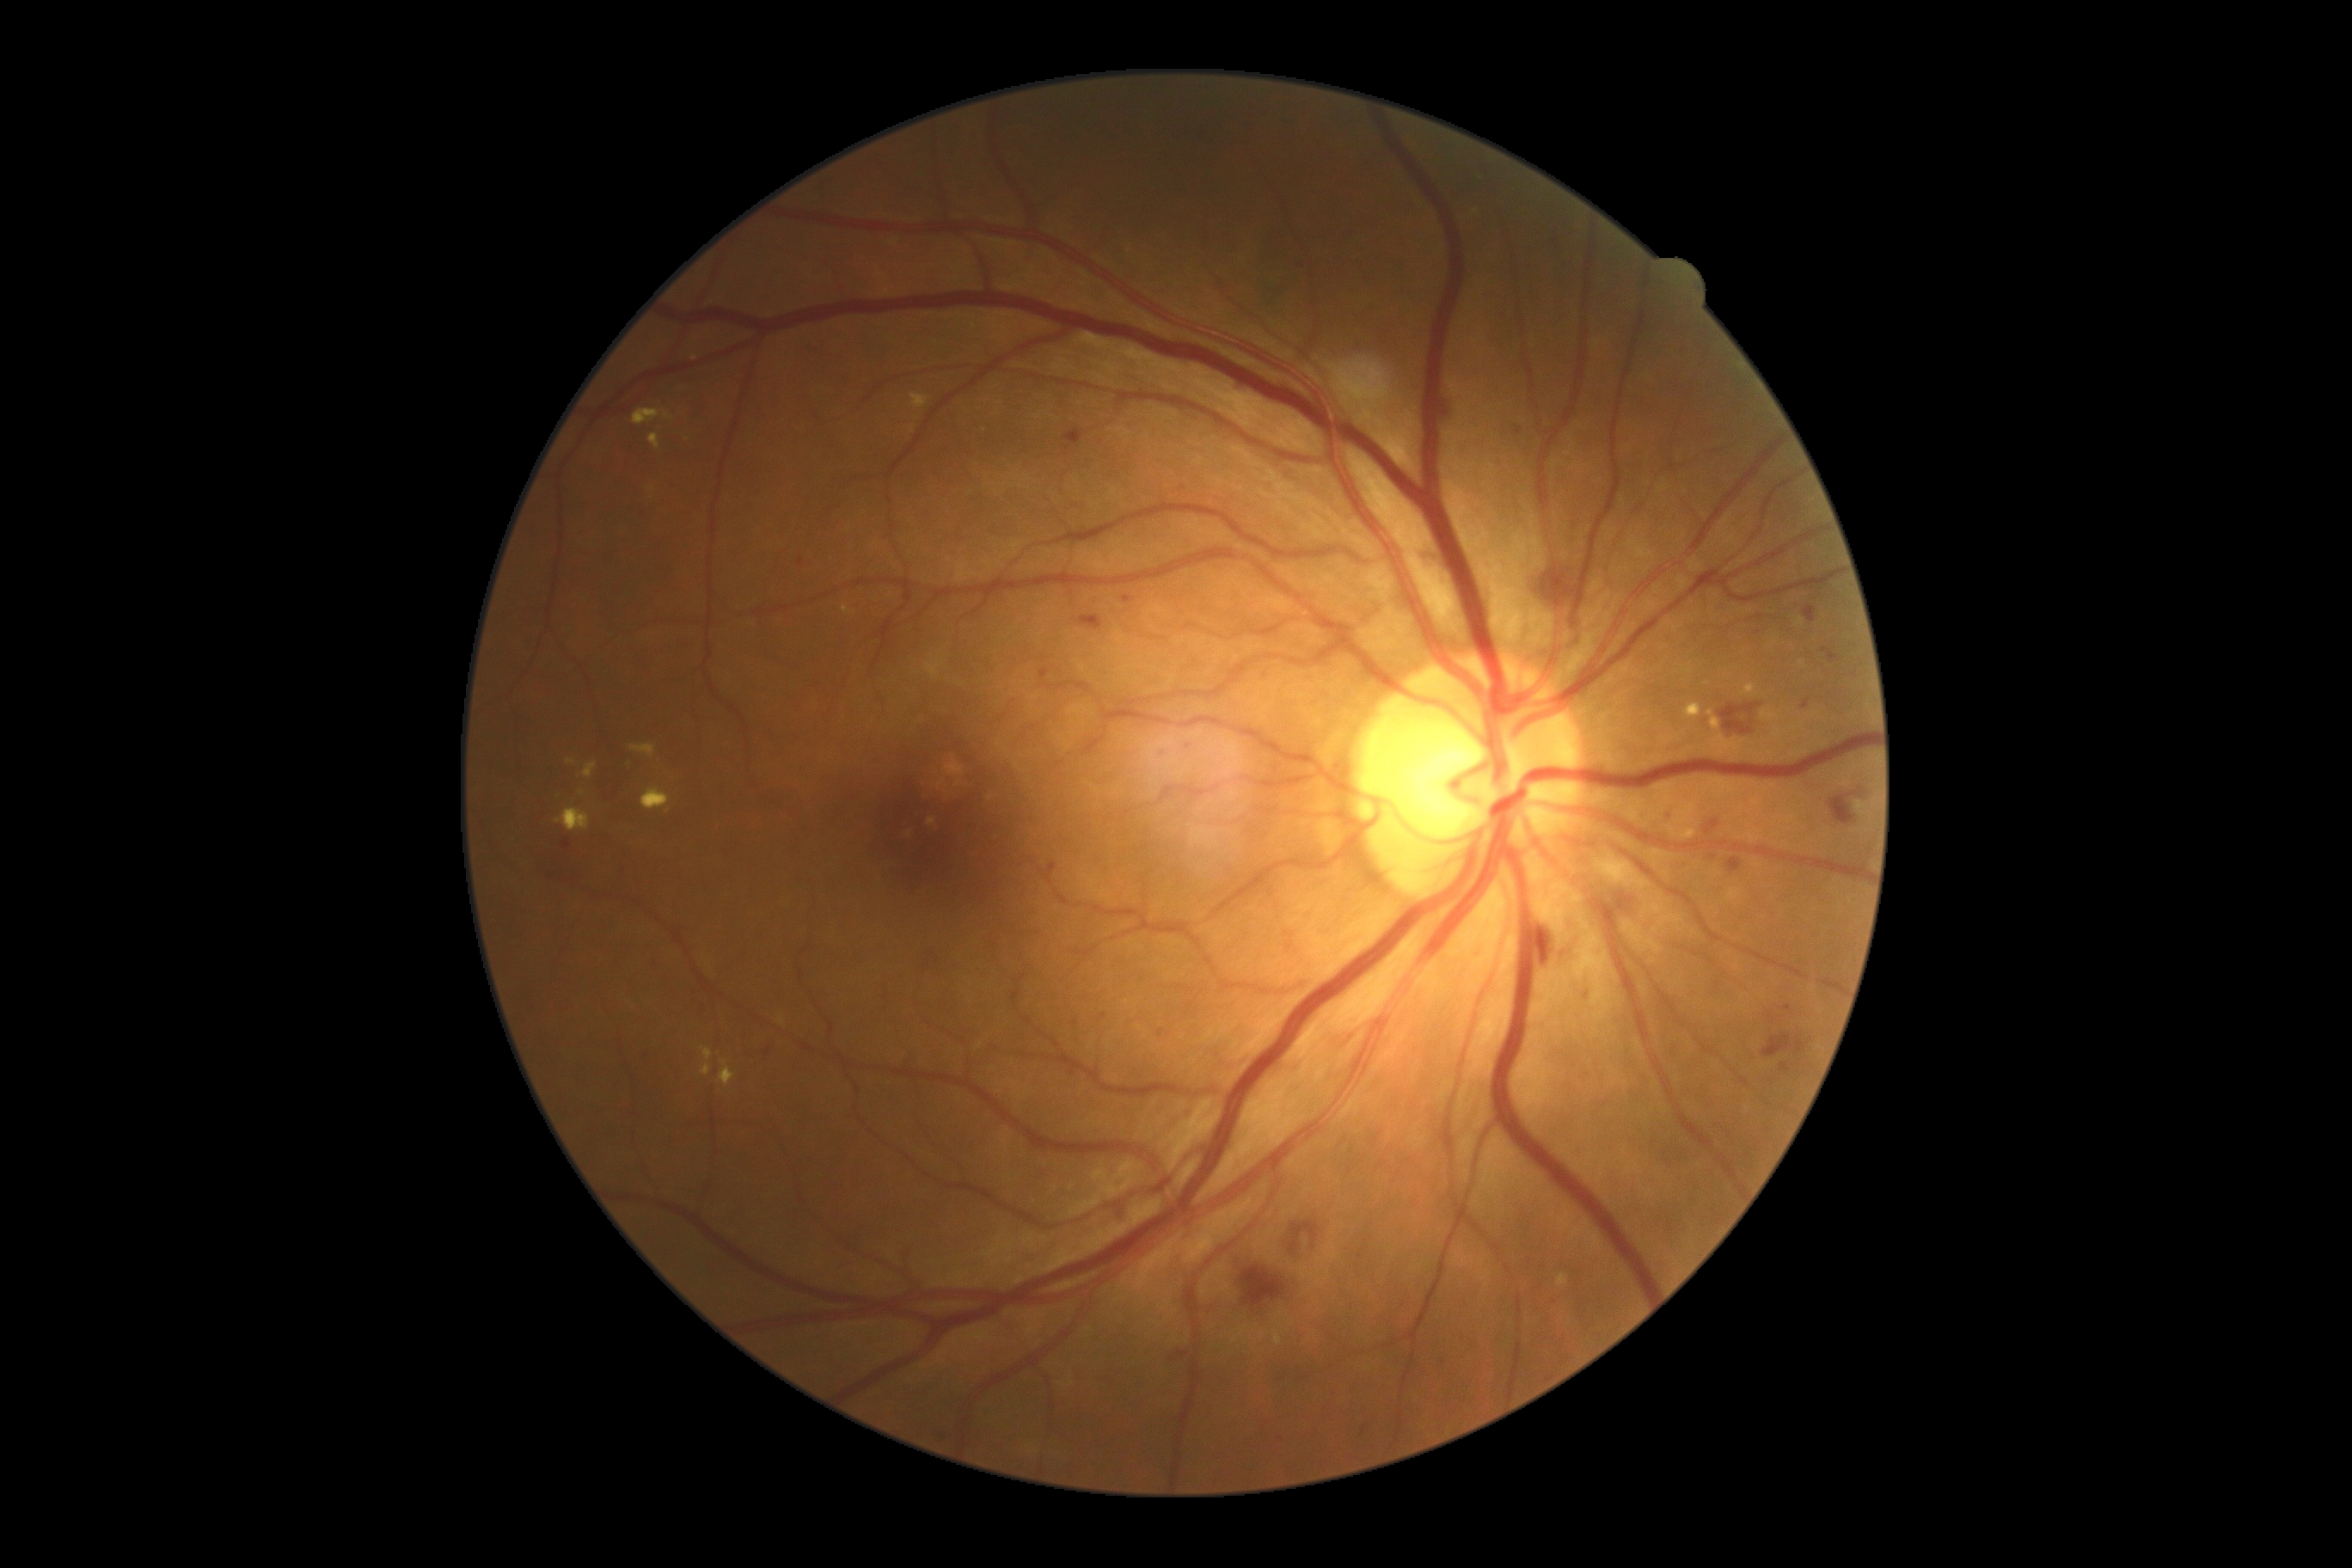
Findings:
– retinopathy: grade 2 (moderate NPDR) — more than just microaneurysms but less than severe NPDR